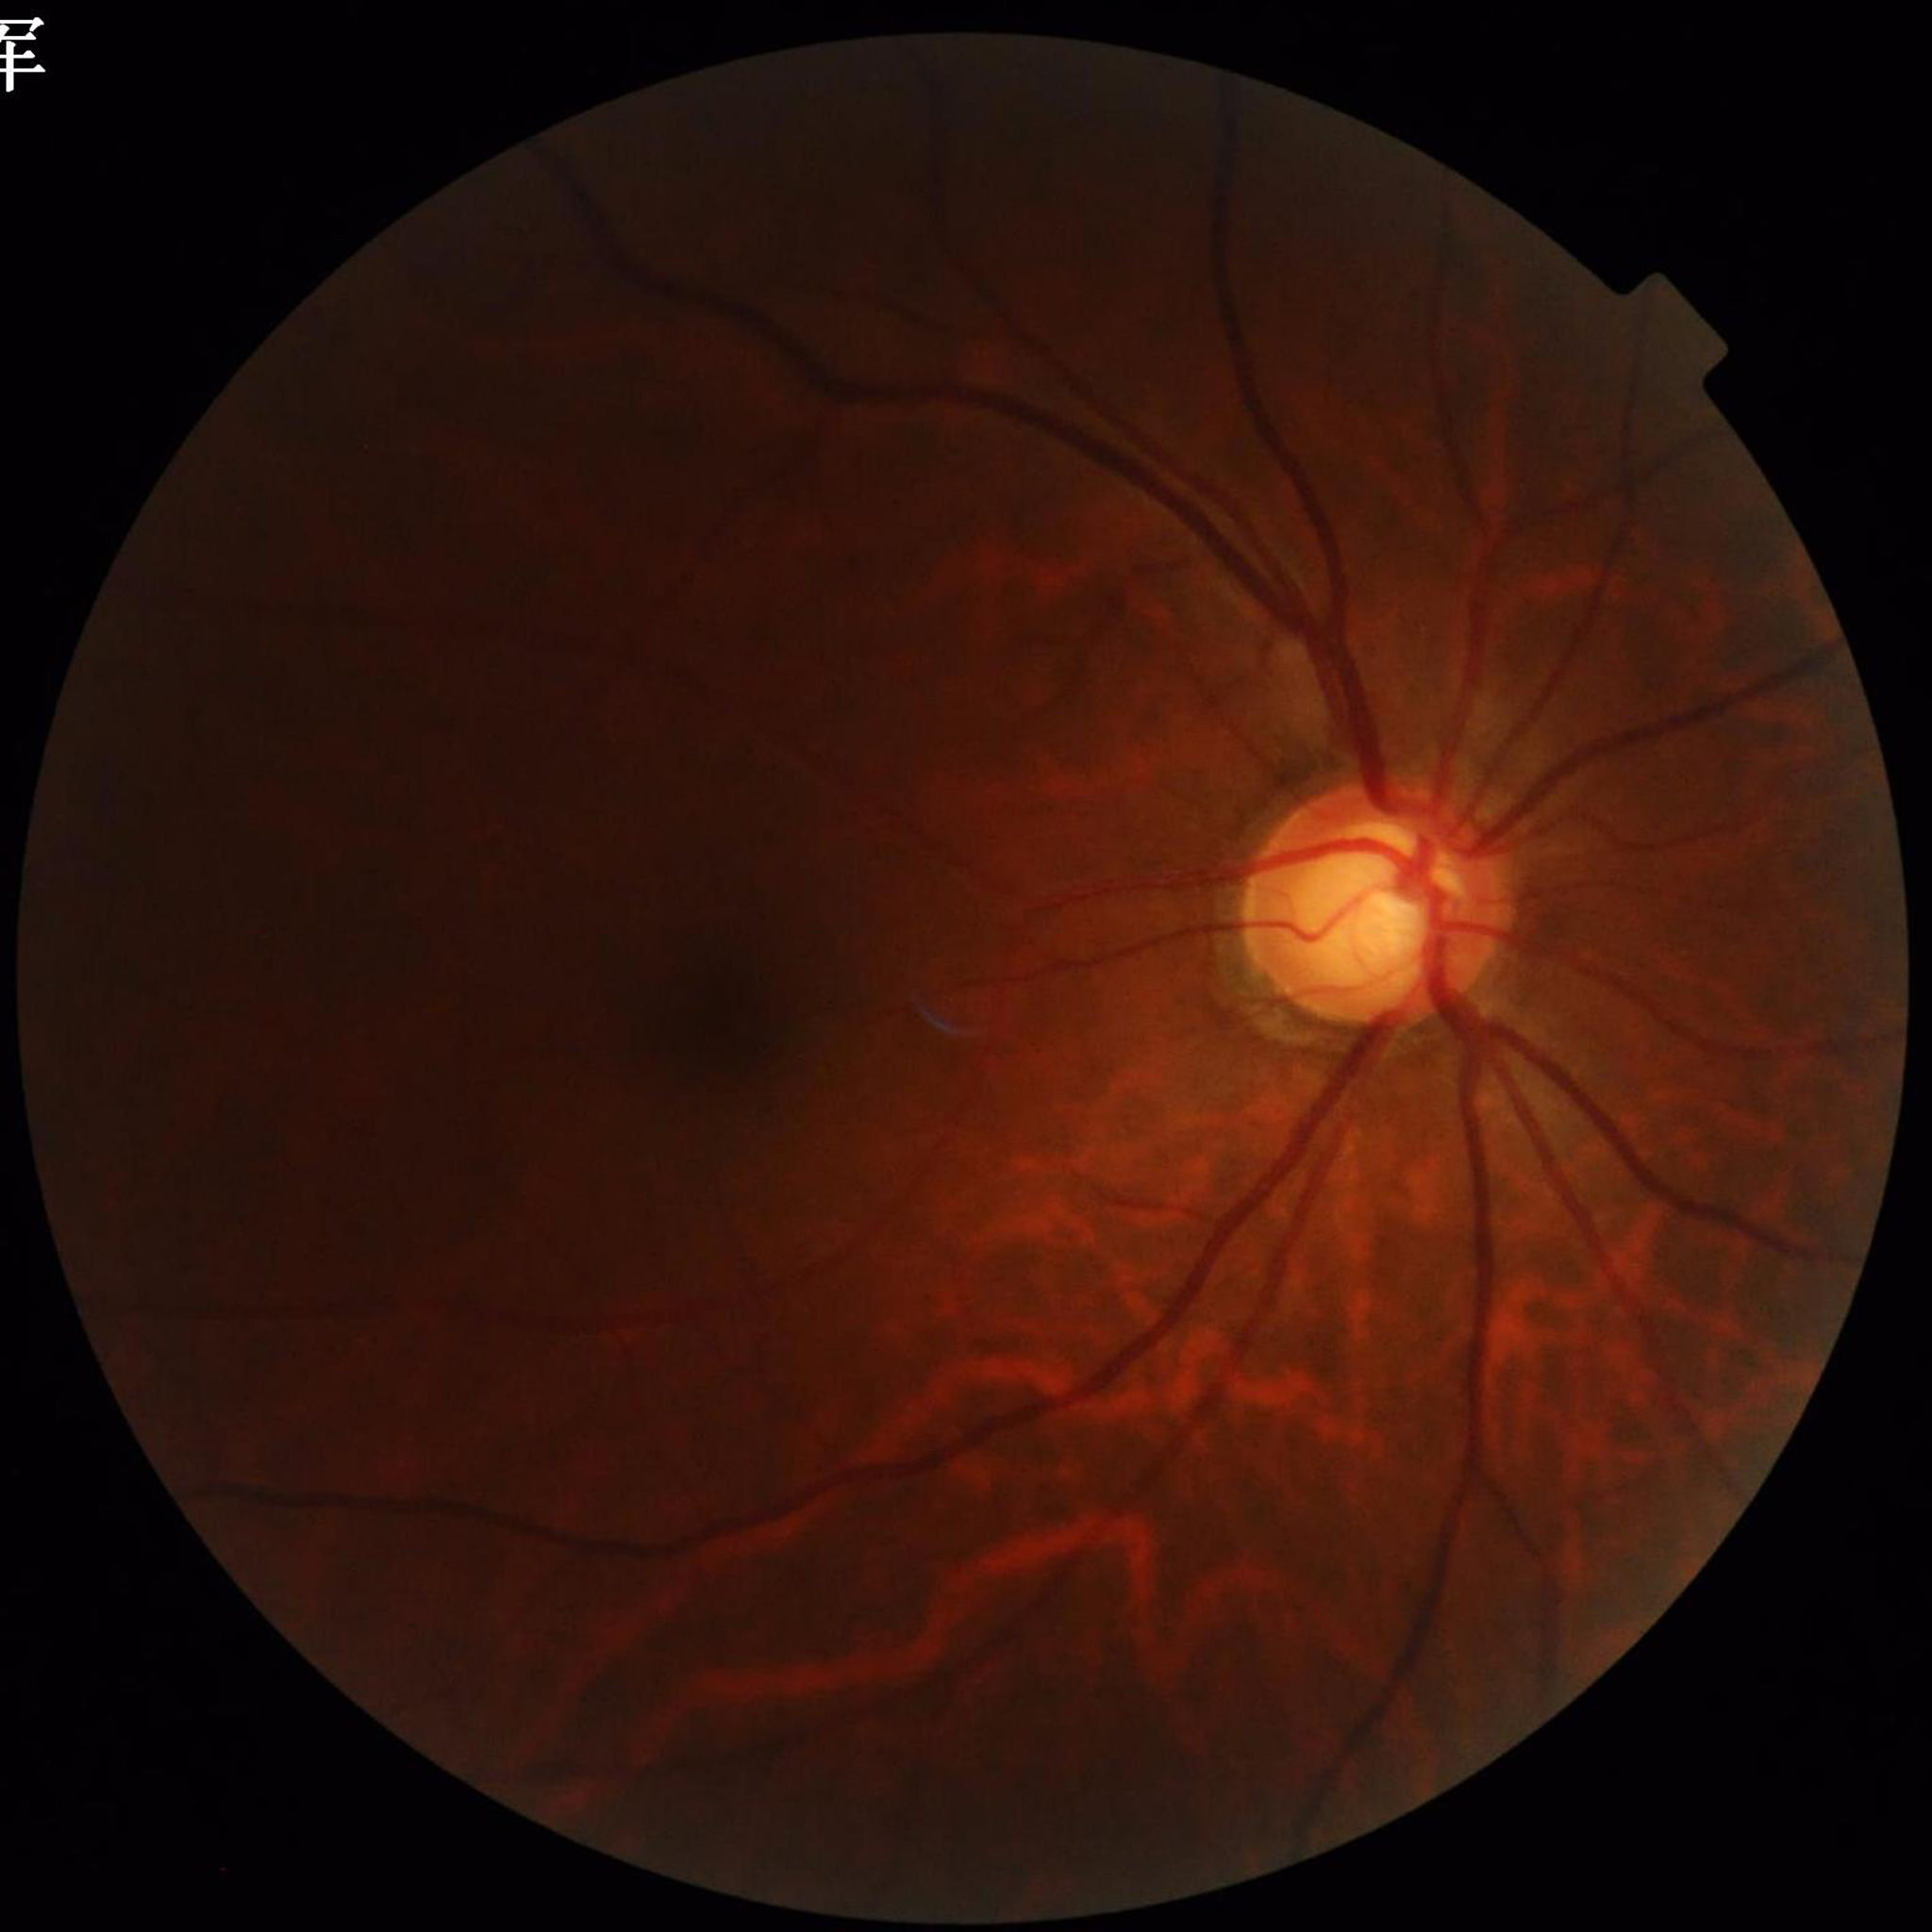

Retinal fundus photograph from a patient with glaucoma.